RetCam wide-field infant fundus image · 640x480: 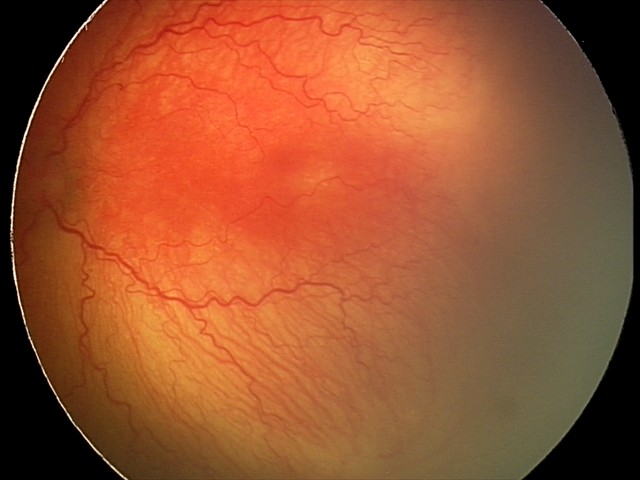

Plus disease present. Screening examination consistent with aggressive ROP (A-ROP).